Optic nerve head crop, 240 x 240 pixels: 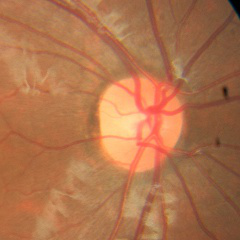

Showing no signs of glaucoma.